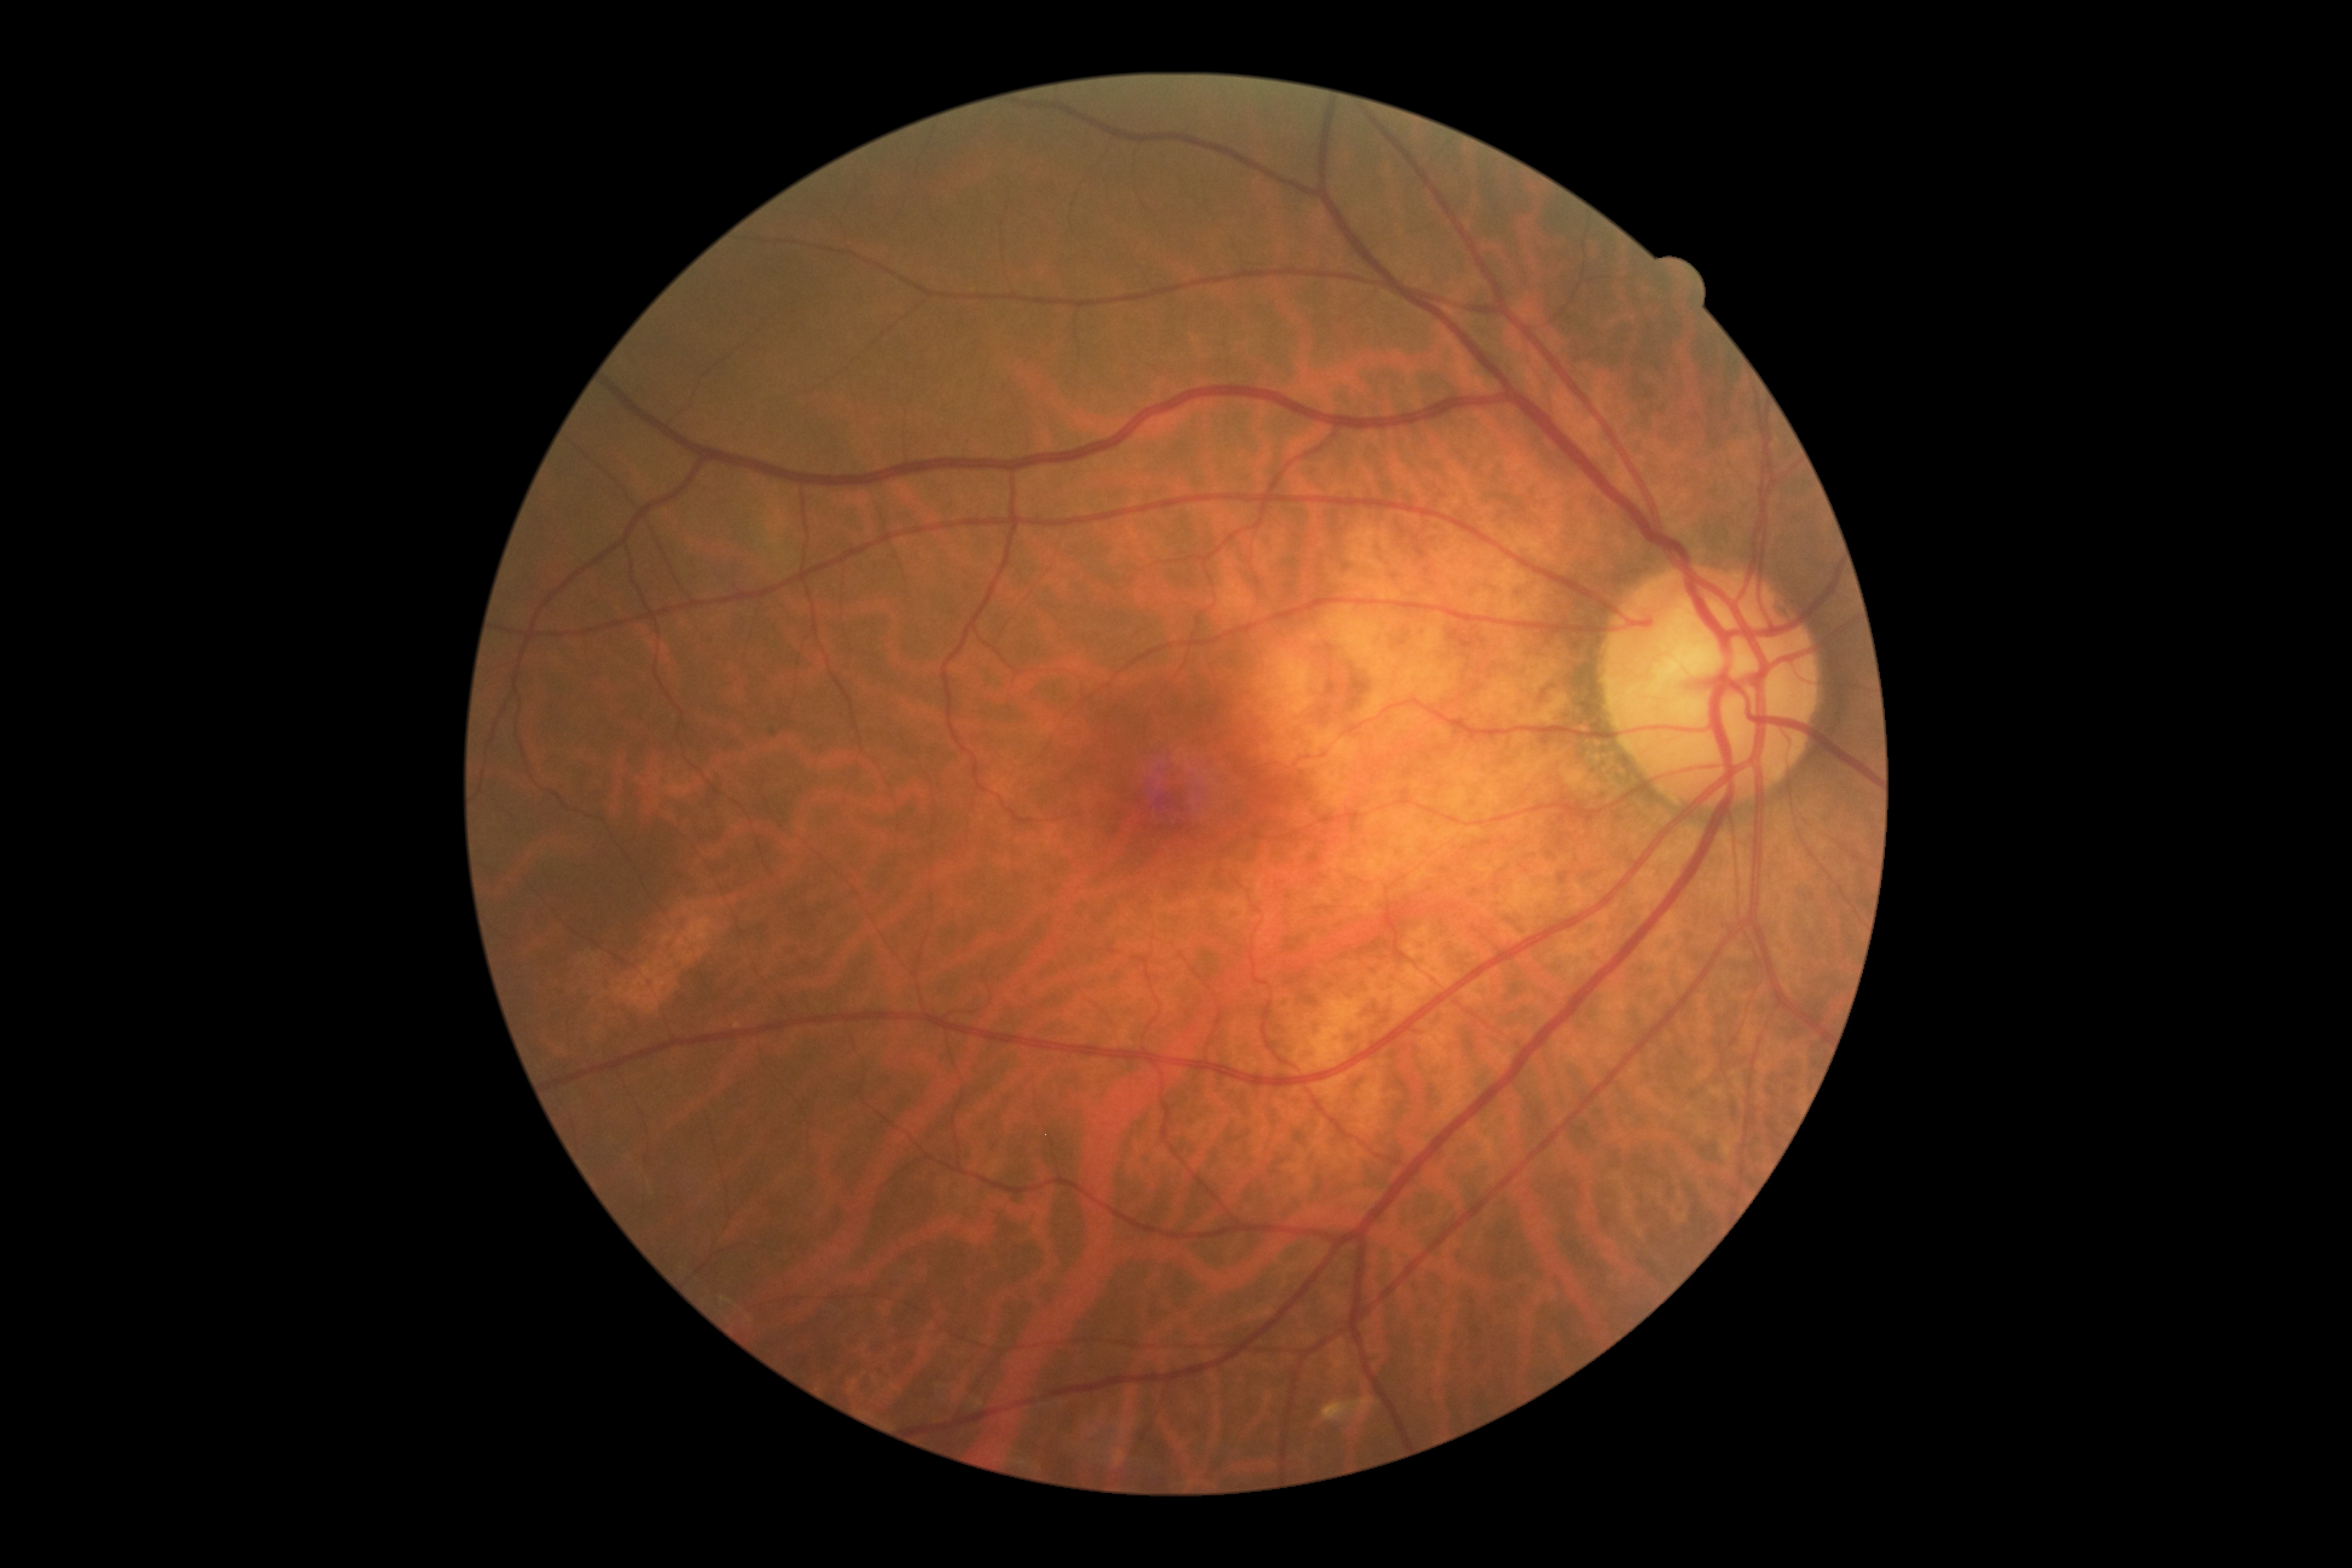 Diabetic retinopathy is grade 0 (no apparent retinopathy).